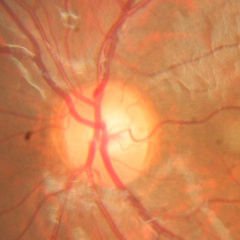
Findings consistent with no glaucomatous optic neuropathy.